Camera: Nidek AFC-330; non-mydriatic fundus camera: 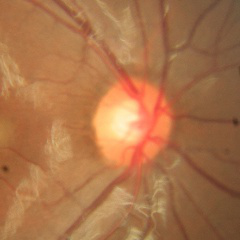
The image shows no glaucomatous findings.